Posterior pole field covering the optic disc and macula; captured after pupil dilation:
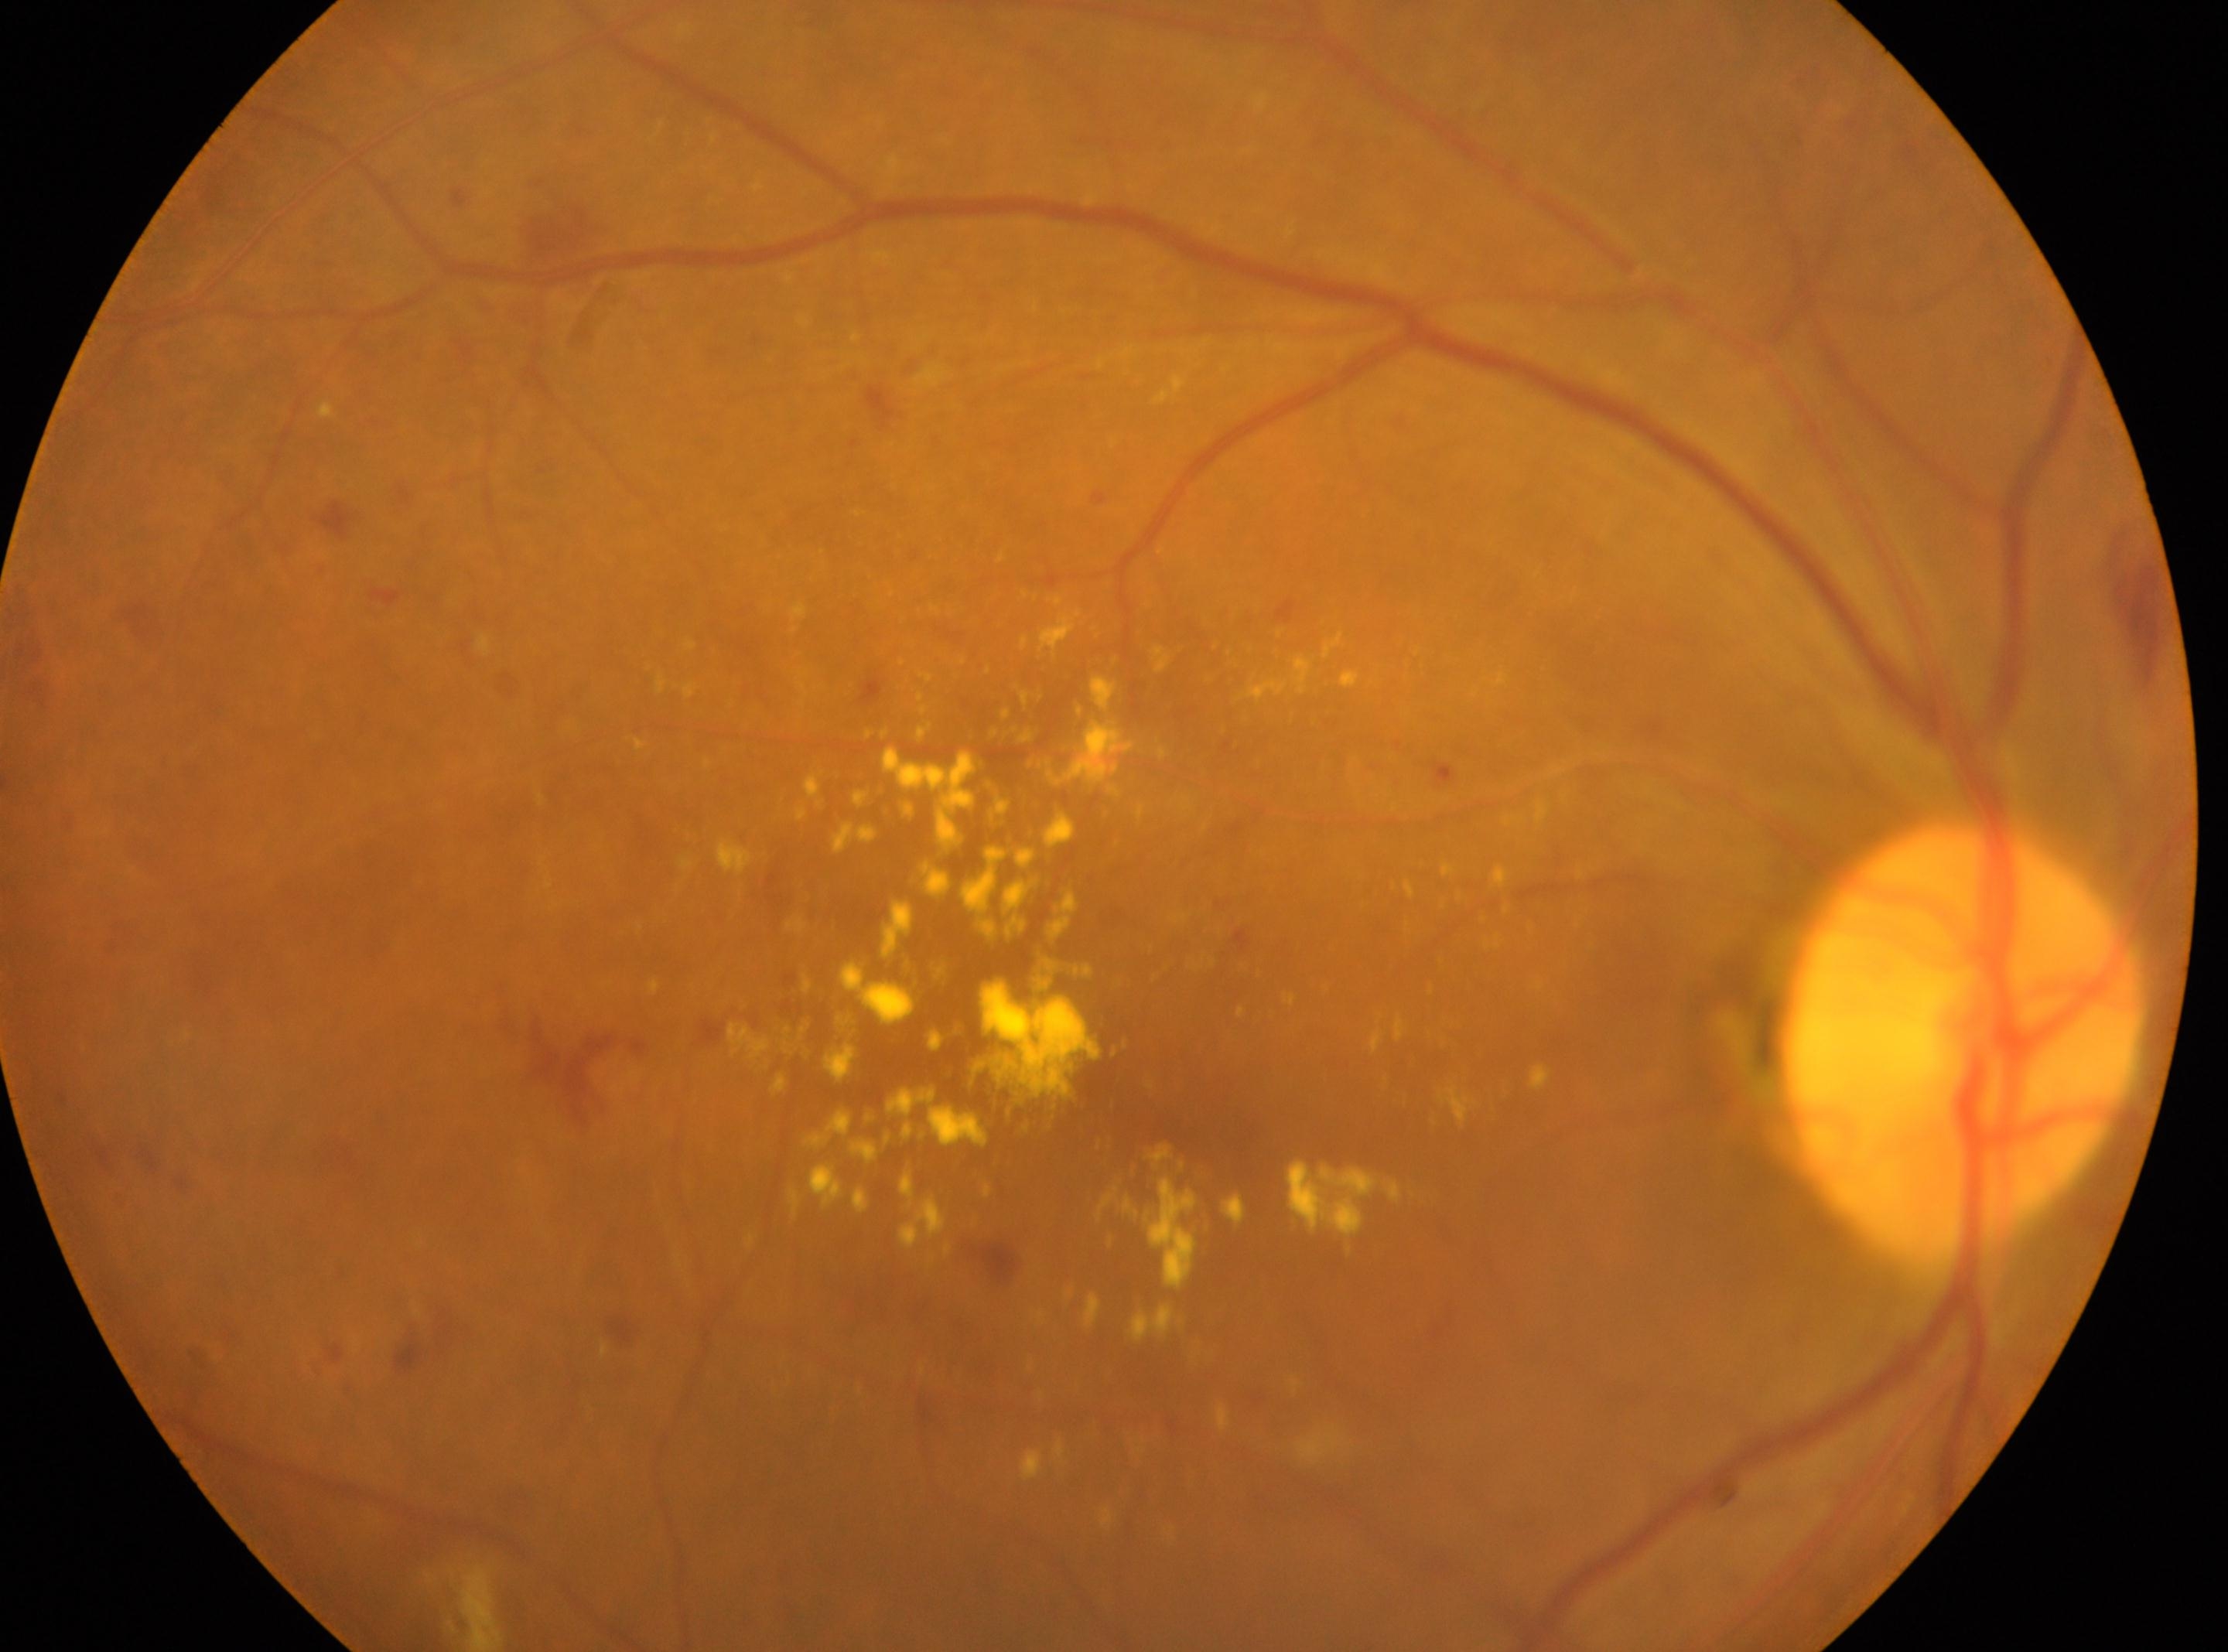 The image shows the OD.
Optic disc: 1961, 1039.
DR grade: 2.
Fovea centralis: 1129, 1084.